FOV: 45 degrees; color fundus photograph: 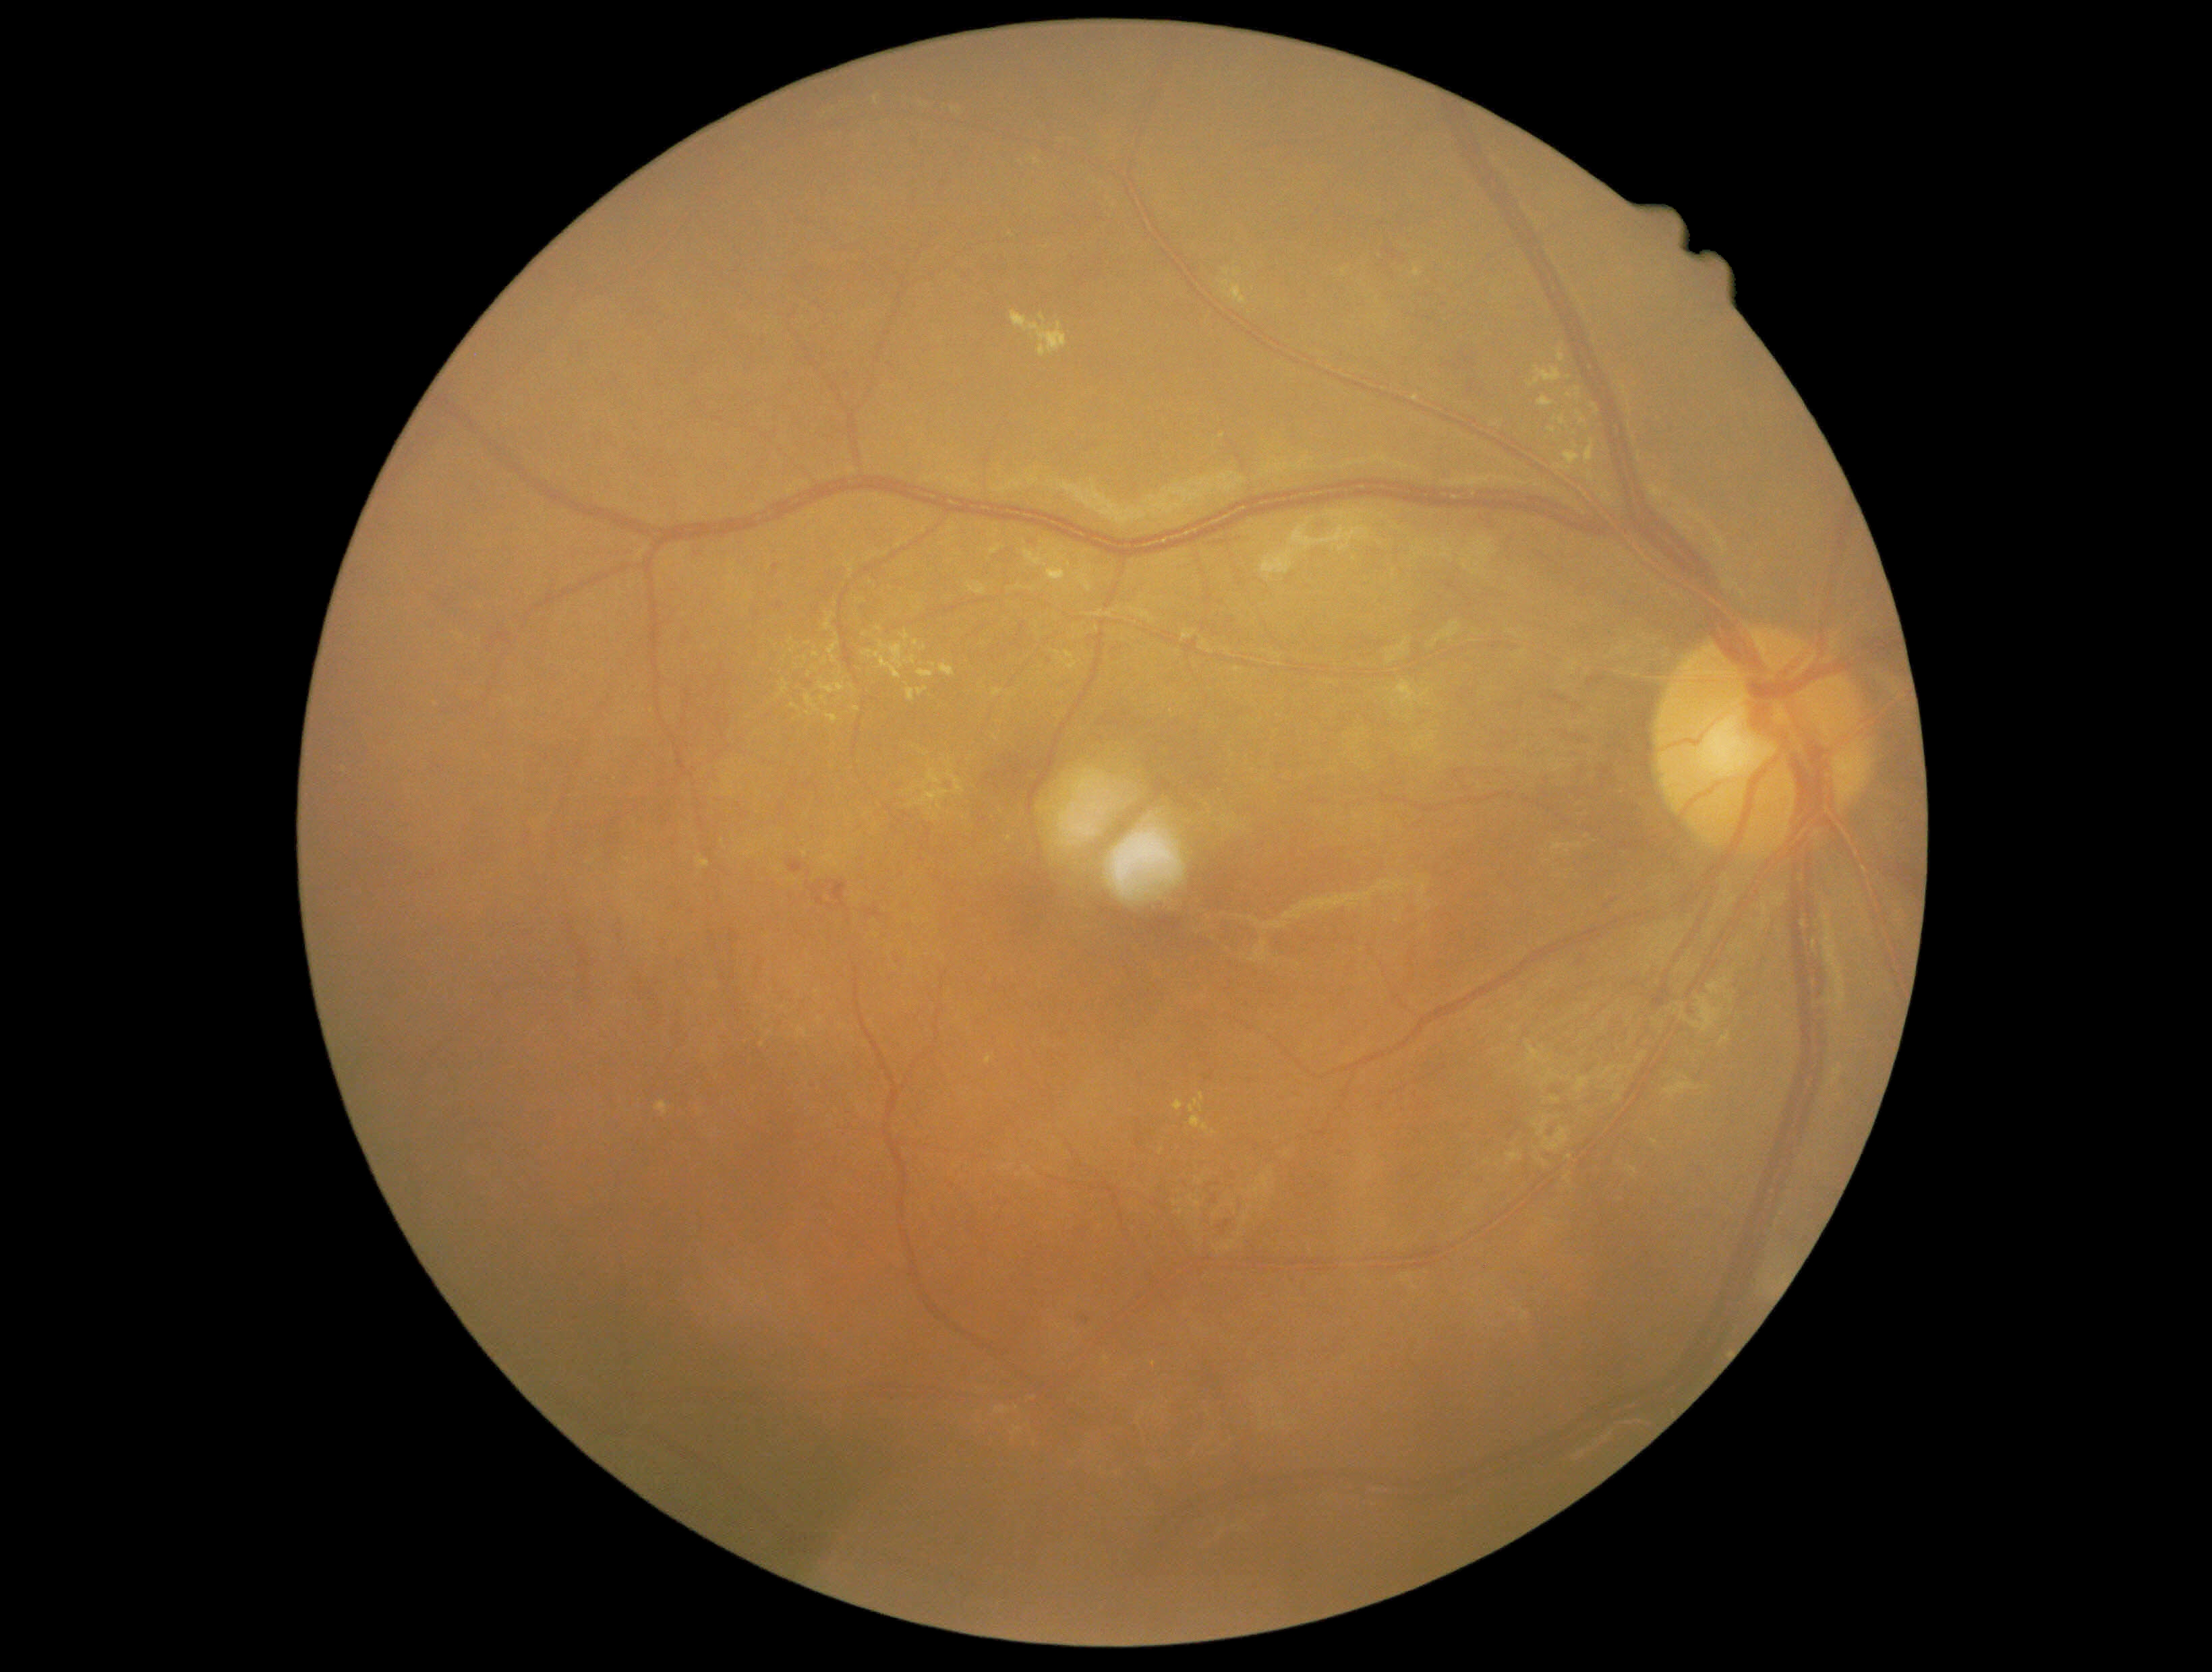

DR class = non-proliferative diabetic retinopathy
retinopathy = 2